640 x 480 pixels · wide-field fundus photograph of an infant: 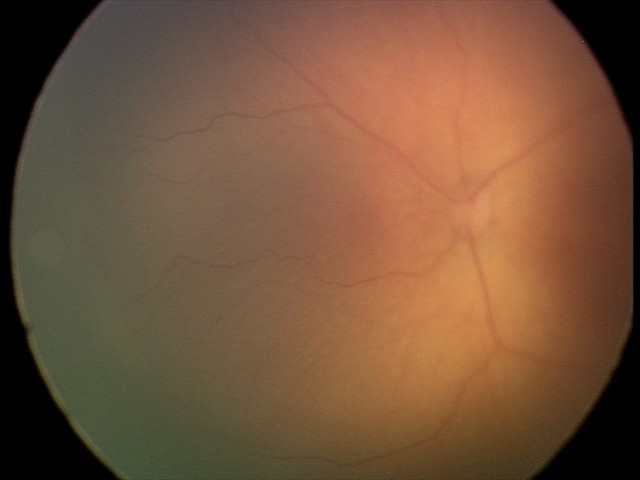
Retinopathy of prematurity (ROP) stage = 1 — demarcation line between vascular and avascular retina.